2212 x 1659 pixels; CFP.
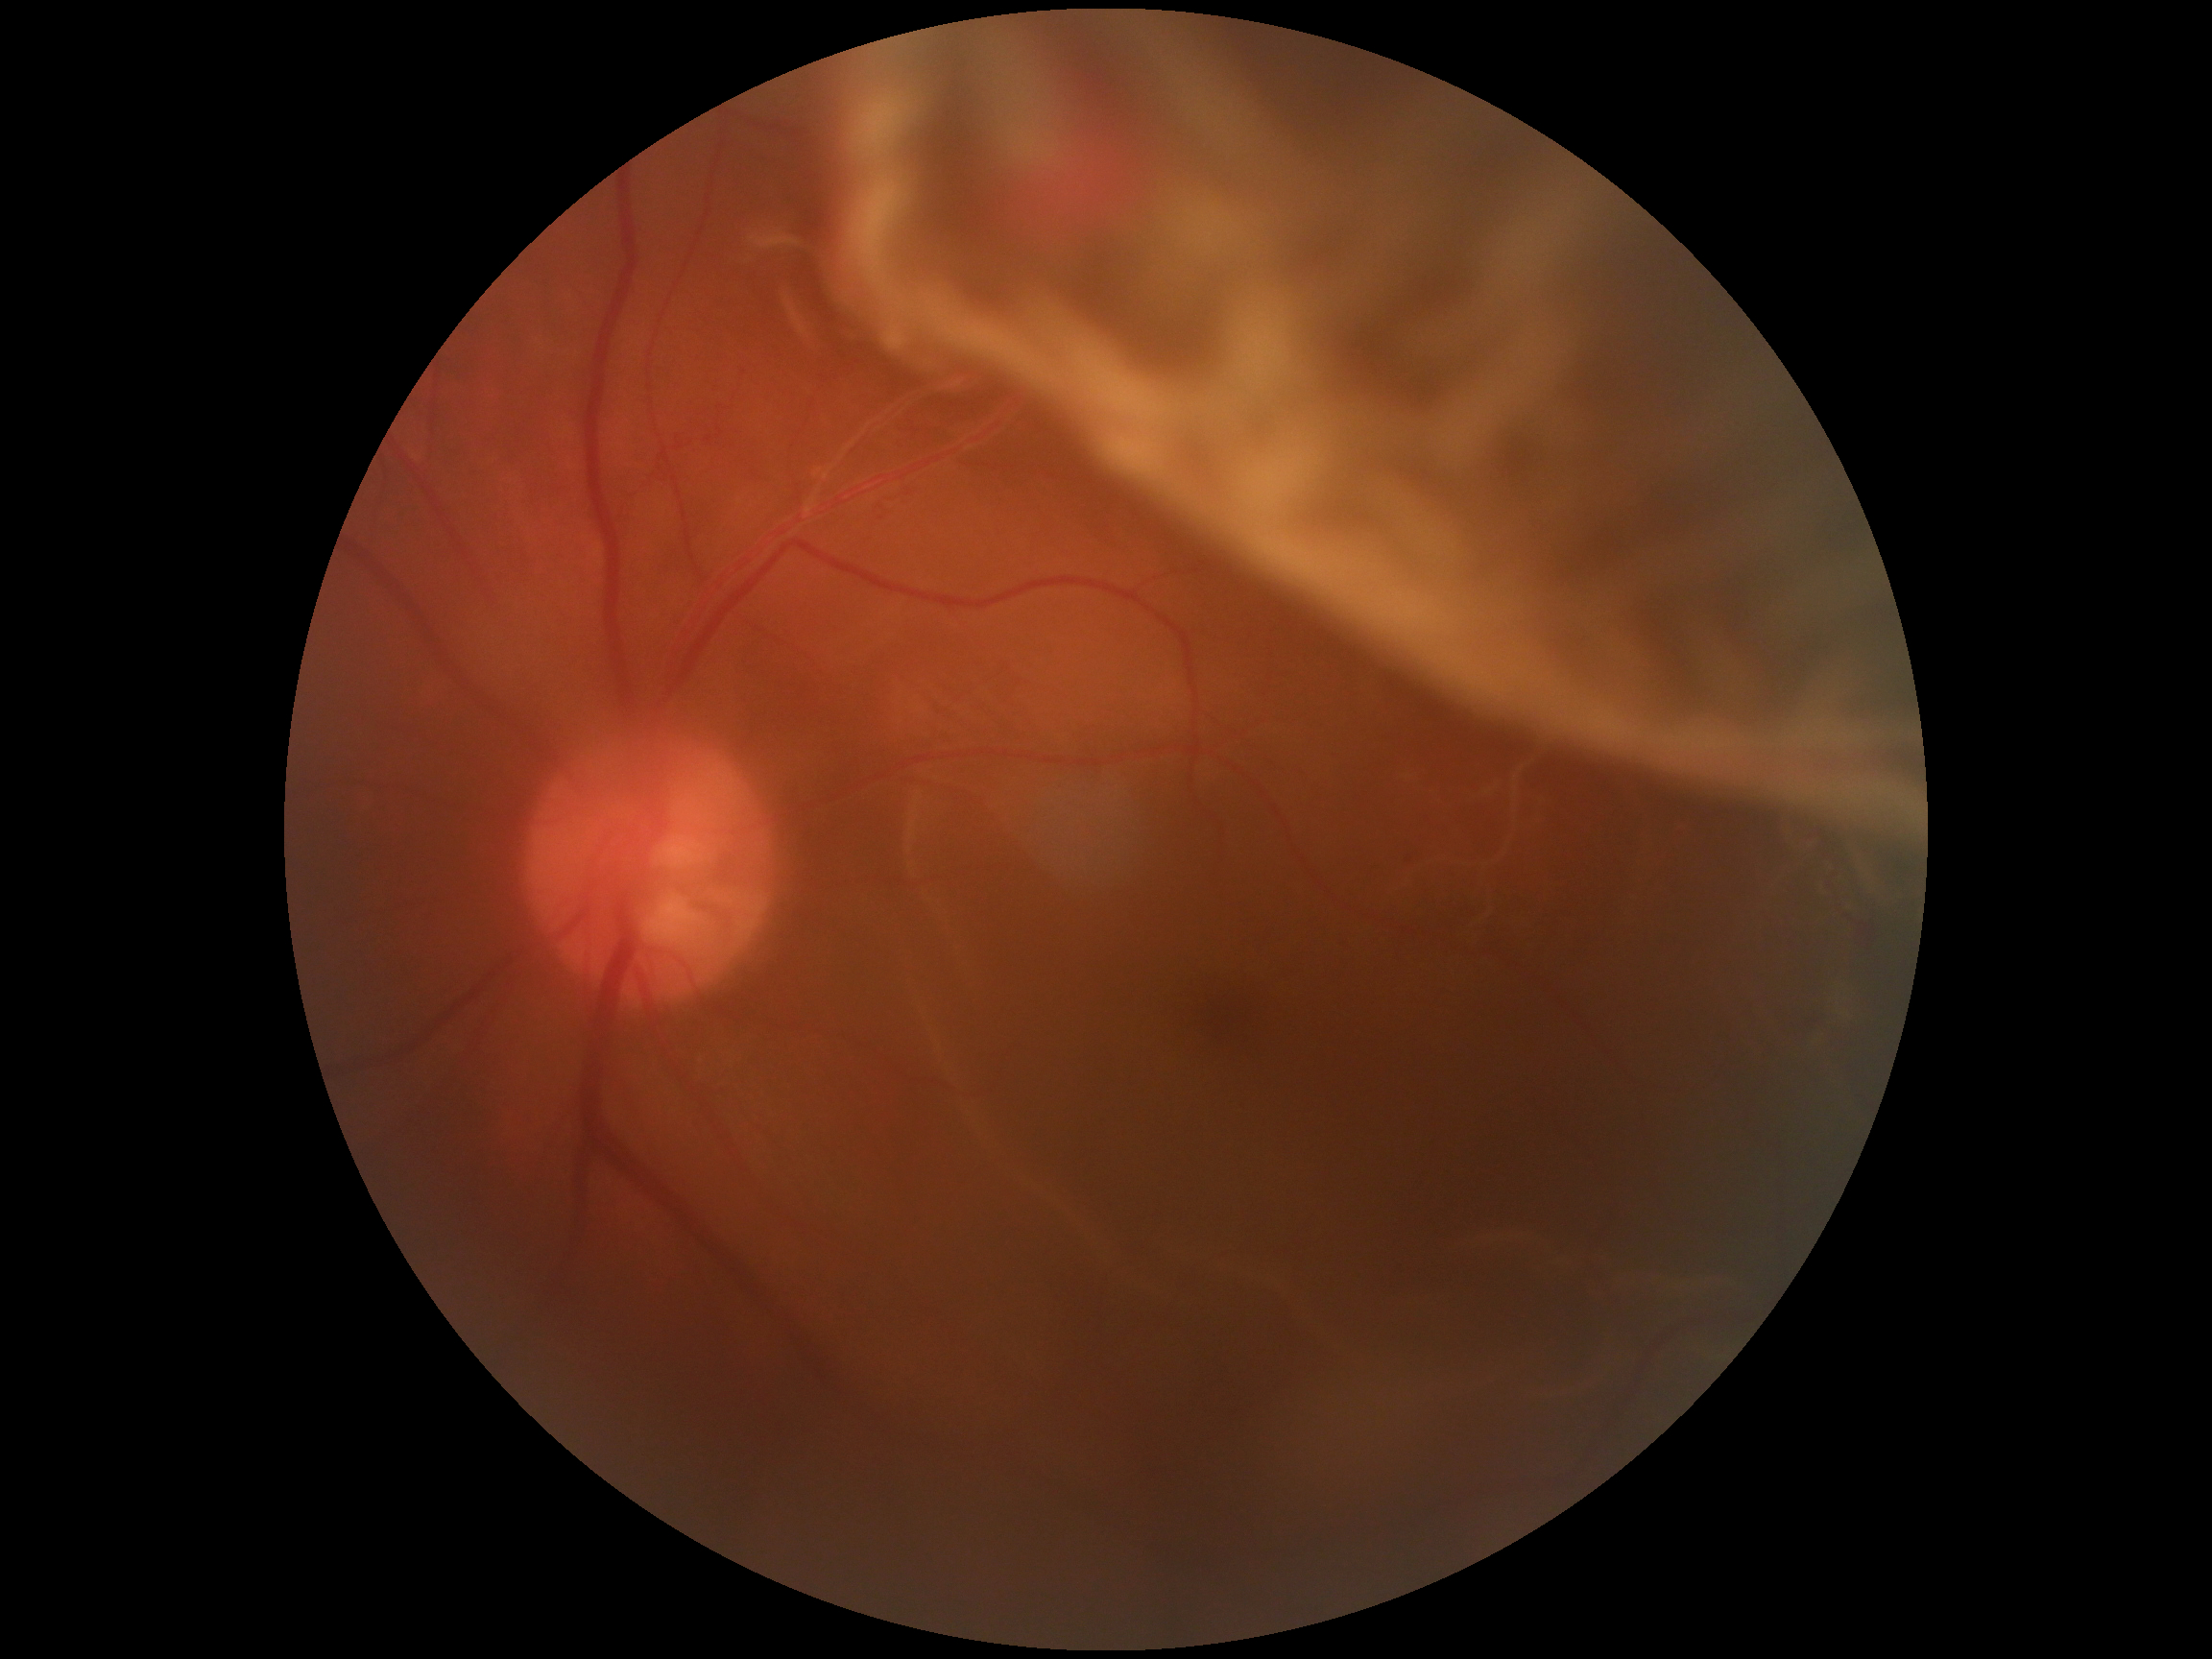 retinopathy@PDR (grade 4).